Modified Davis classification — 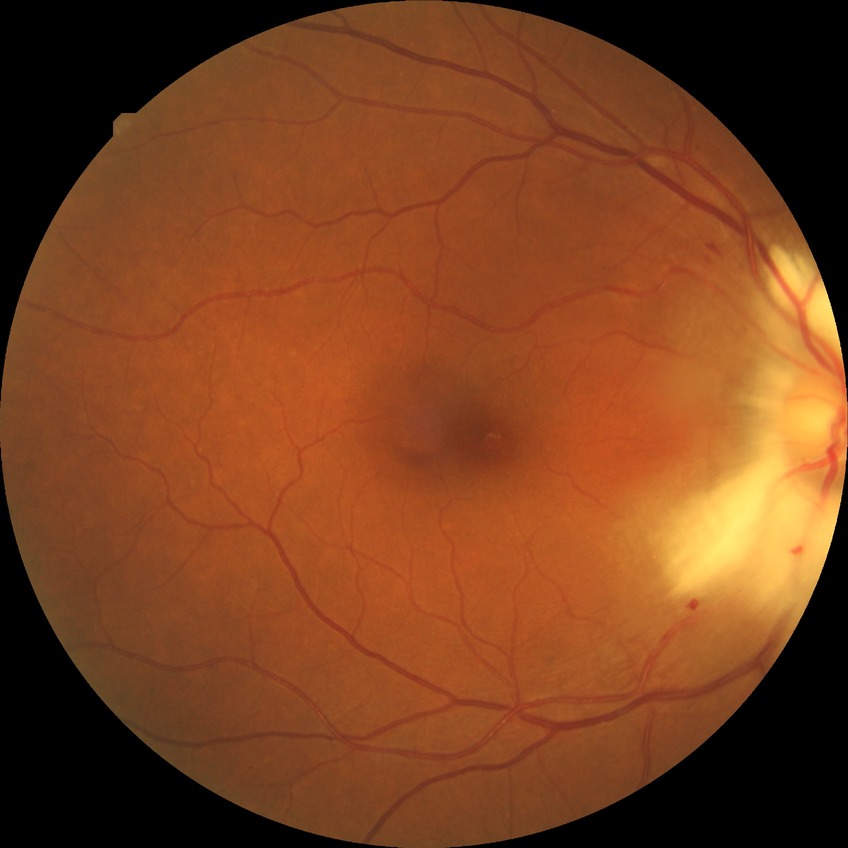 diabetic retinopathy (DR): SDR (simple diabetic retinopathy).